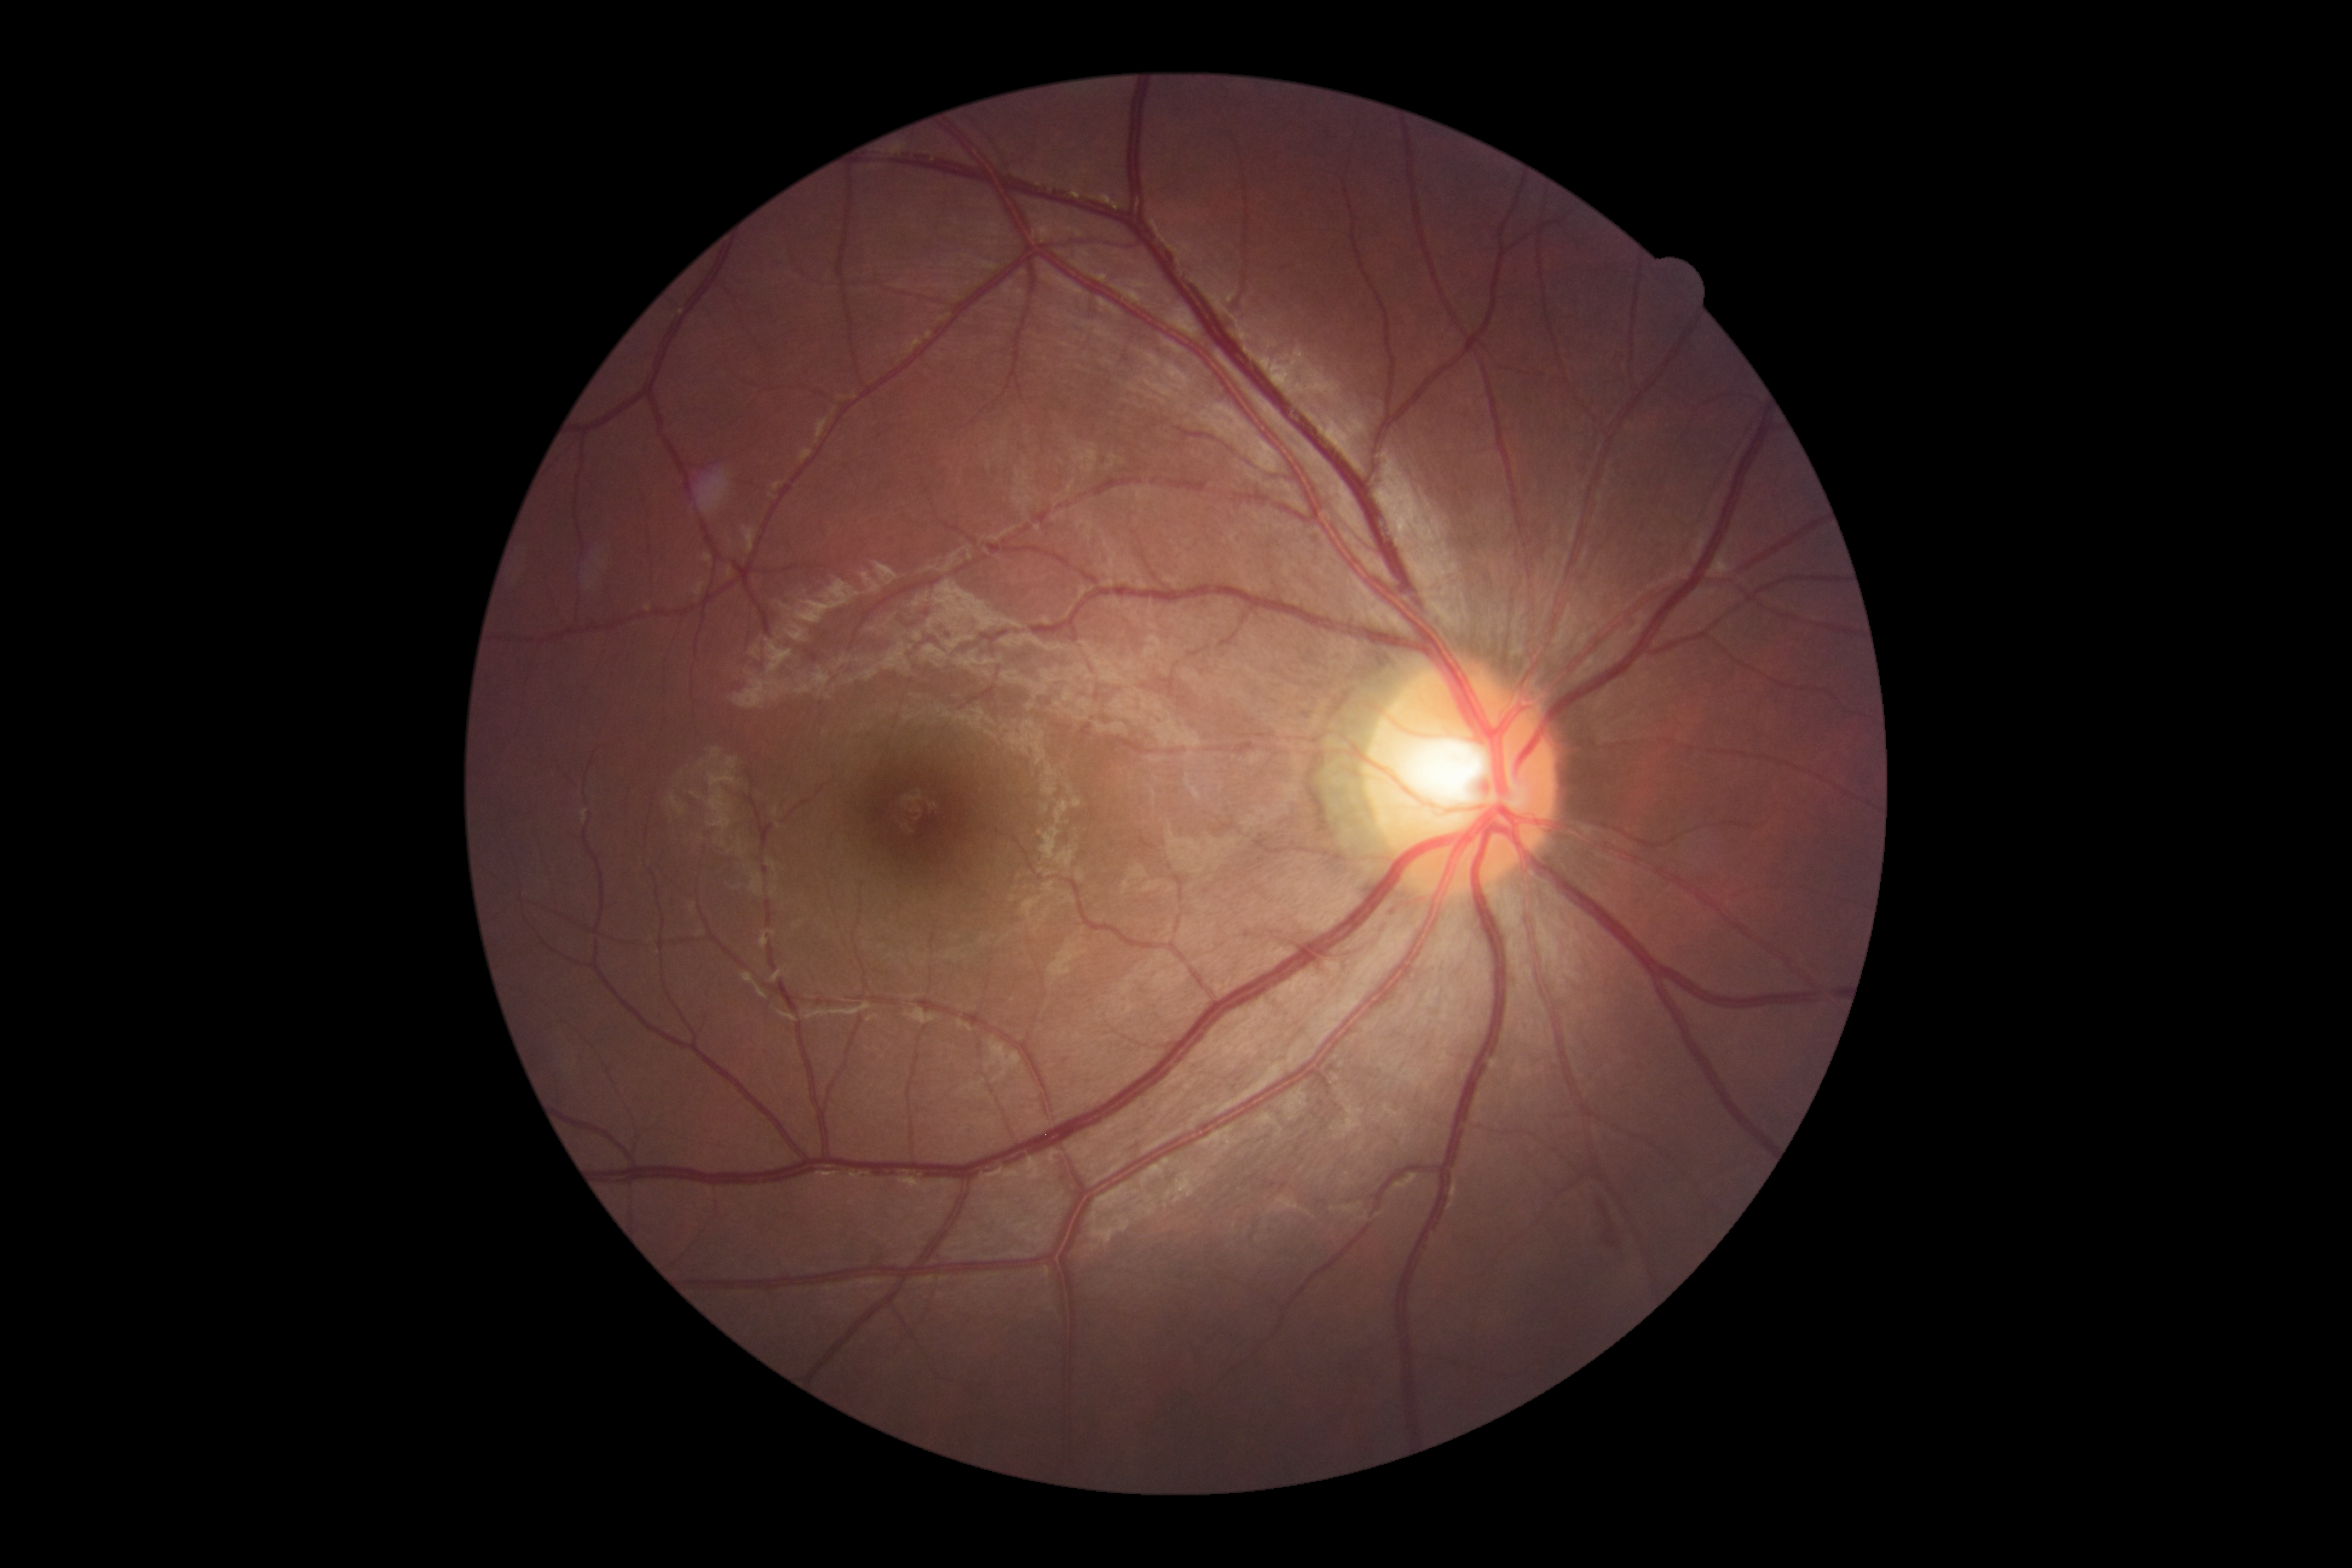

DR class: non-proliferative diabetic retinopathy.
DR grade: 2 (moderate NPDR).